Acquired on the Clarity RetCam 3; wide-field fundus photograph of an infant; 640 x 480 pixels.
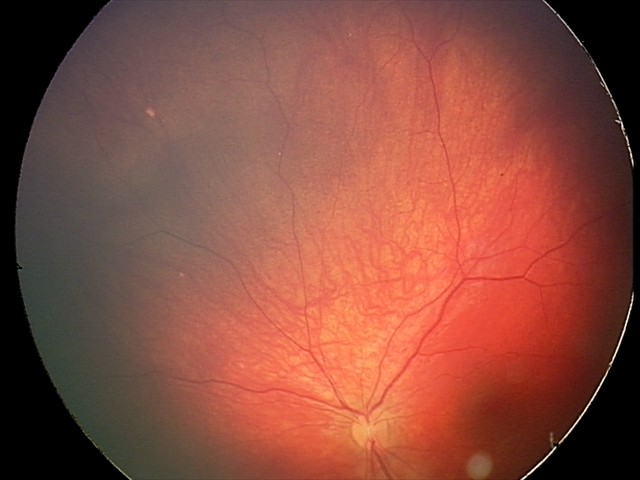

Diagnosis: retinal astrocytic hamartoma.